Nonmydriatic fundus photograph, 848 by 848 pixels
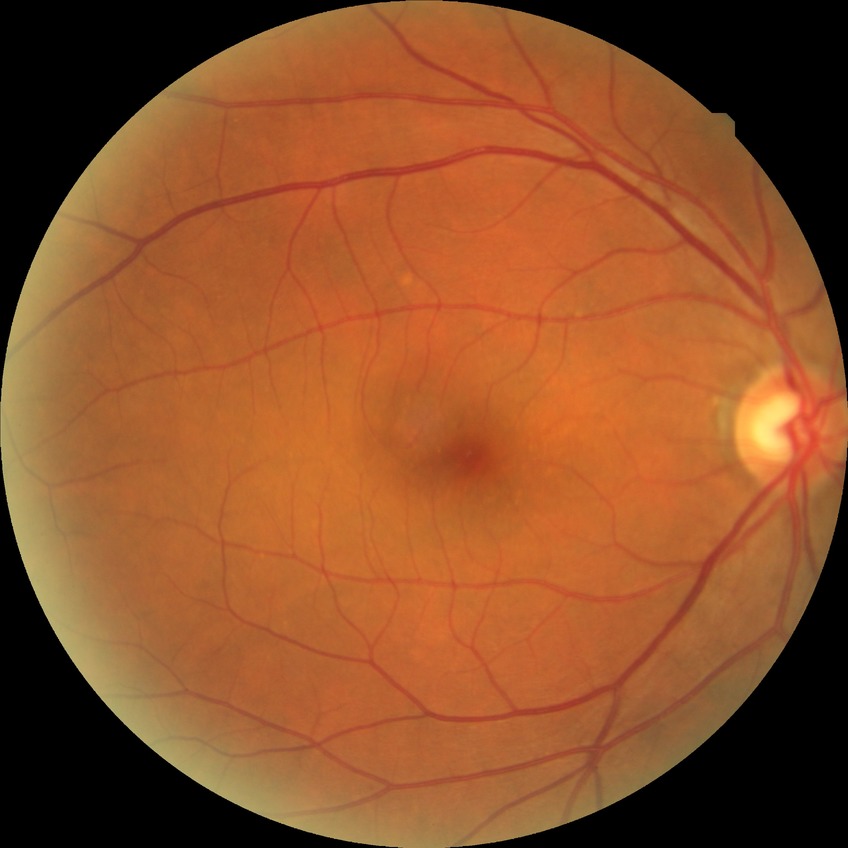 Findings:
* DR — SDR